45° field of view:
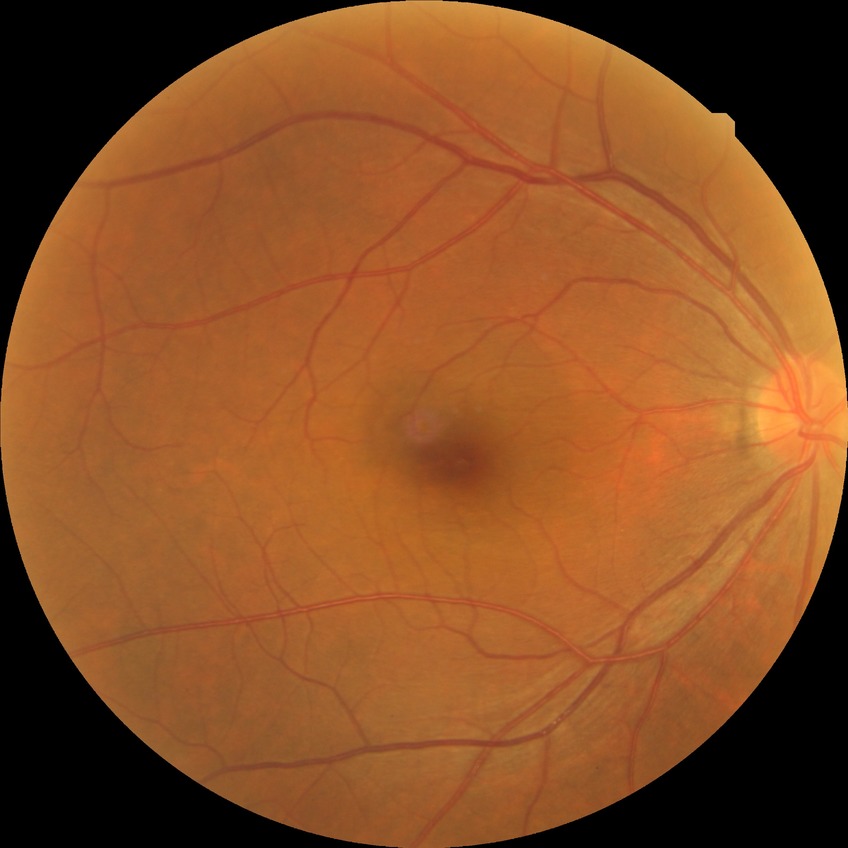

modified Davis classification: no diabetic retinopathy.